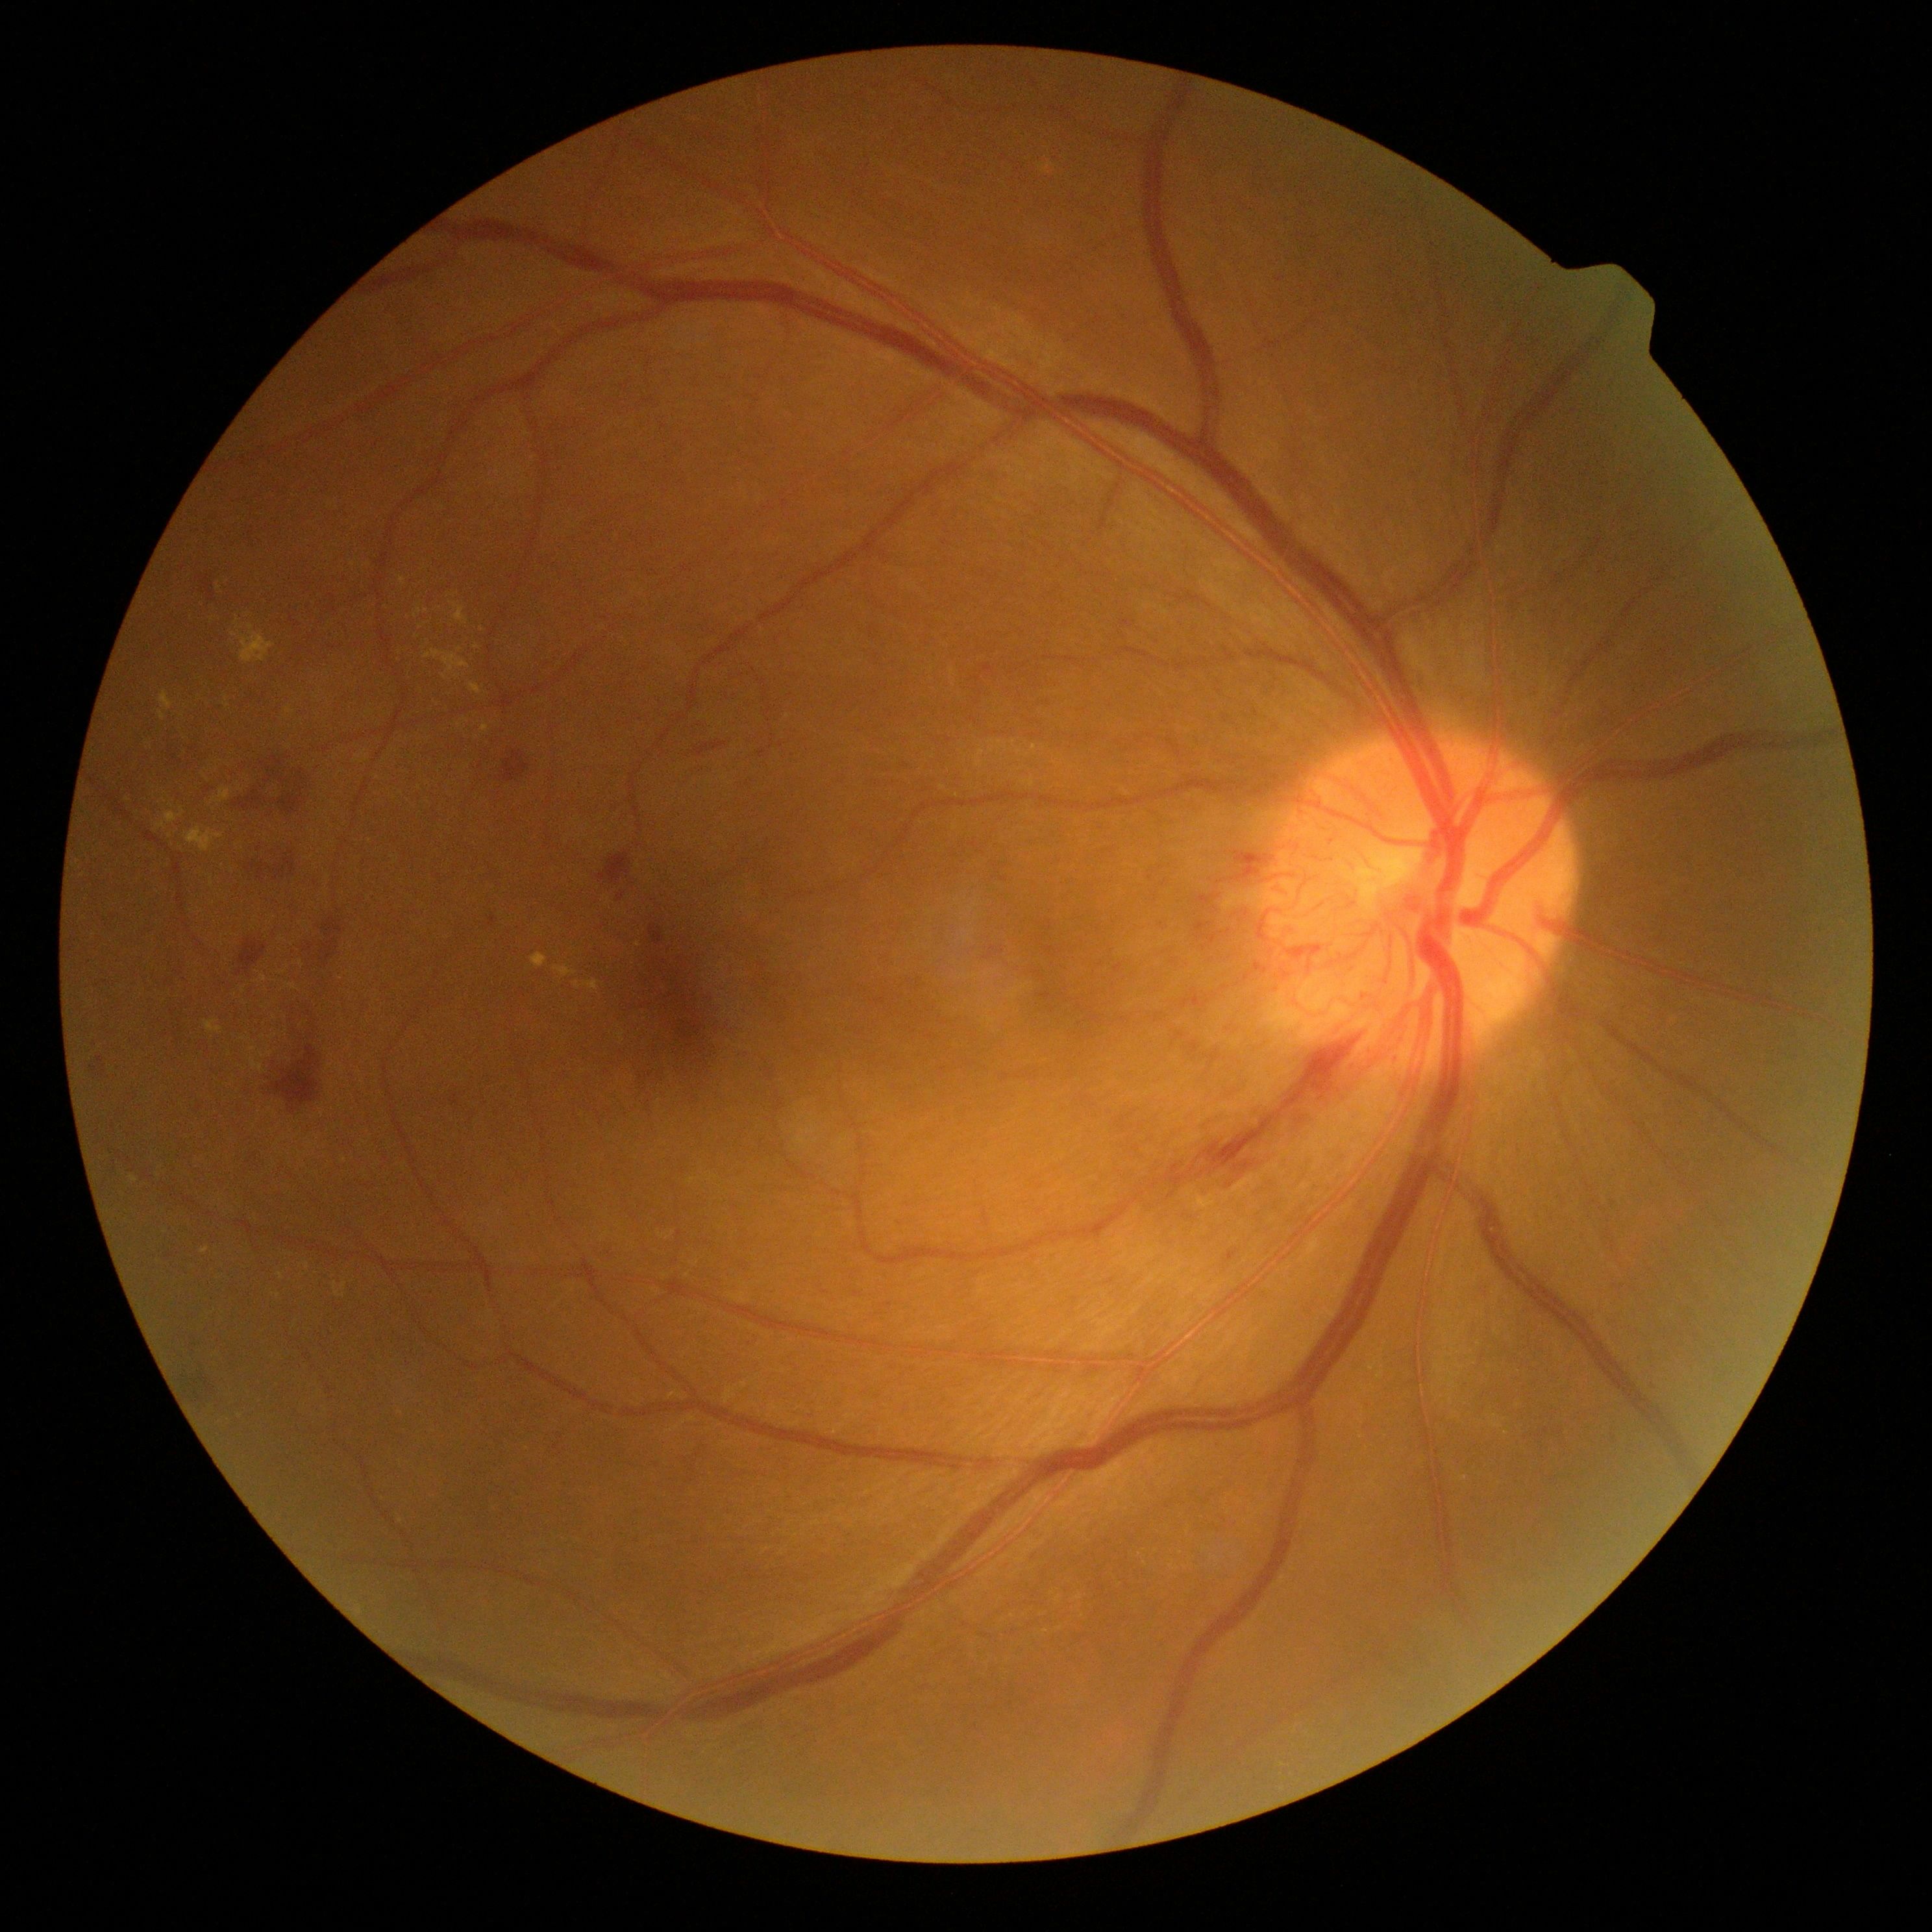

- DR class — proliferative diabetic retinopathy
- retinopathy grade — proliferative diabetic retinopathy (4)